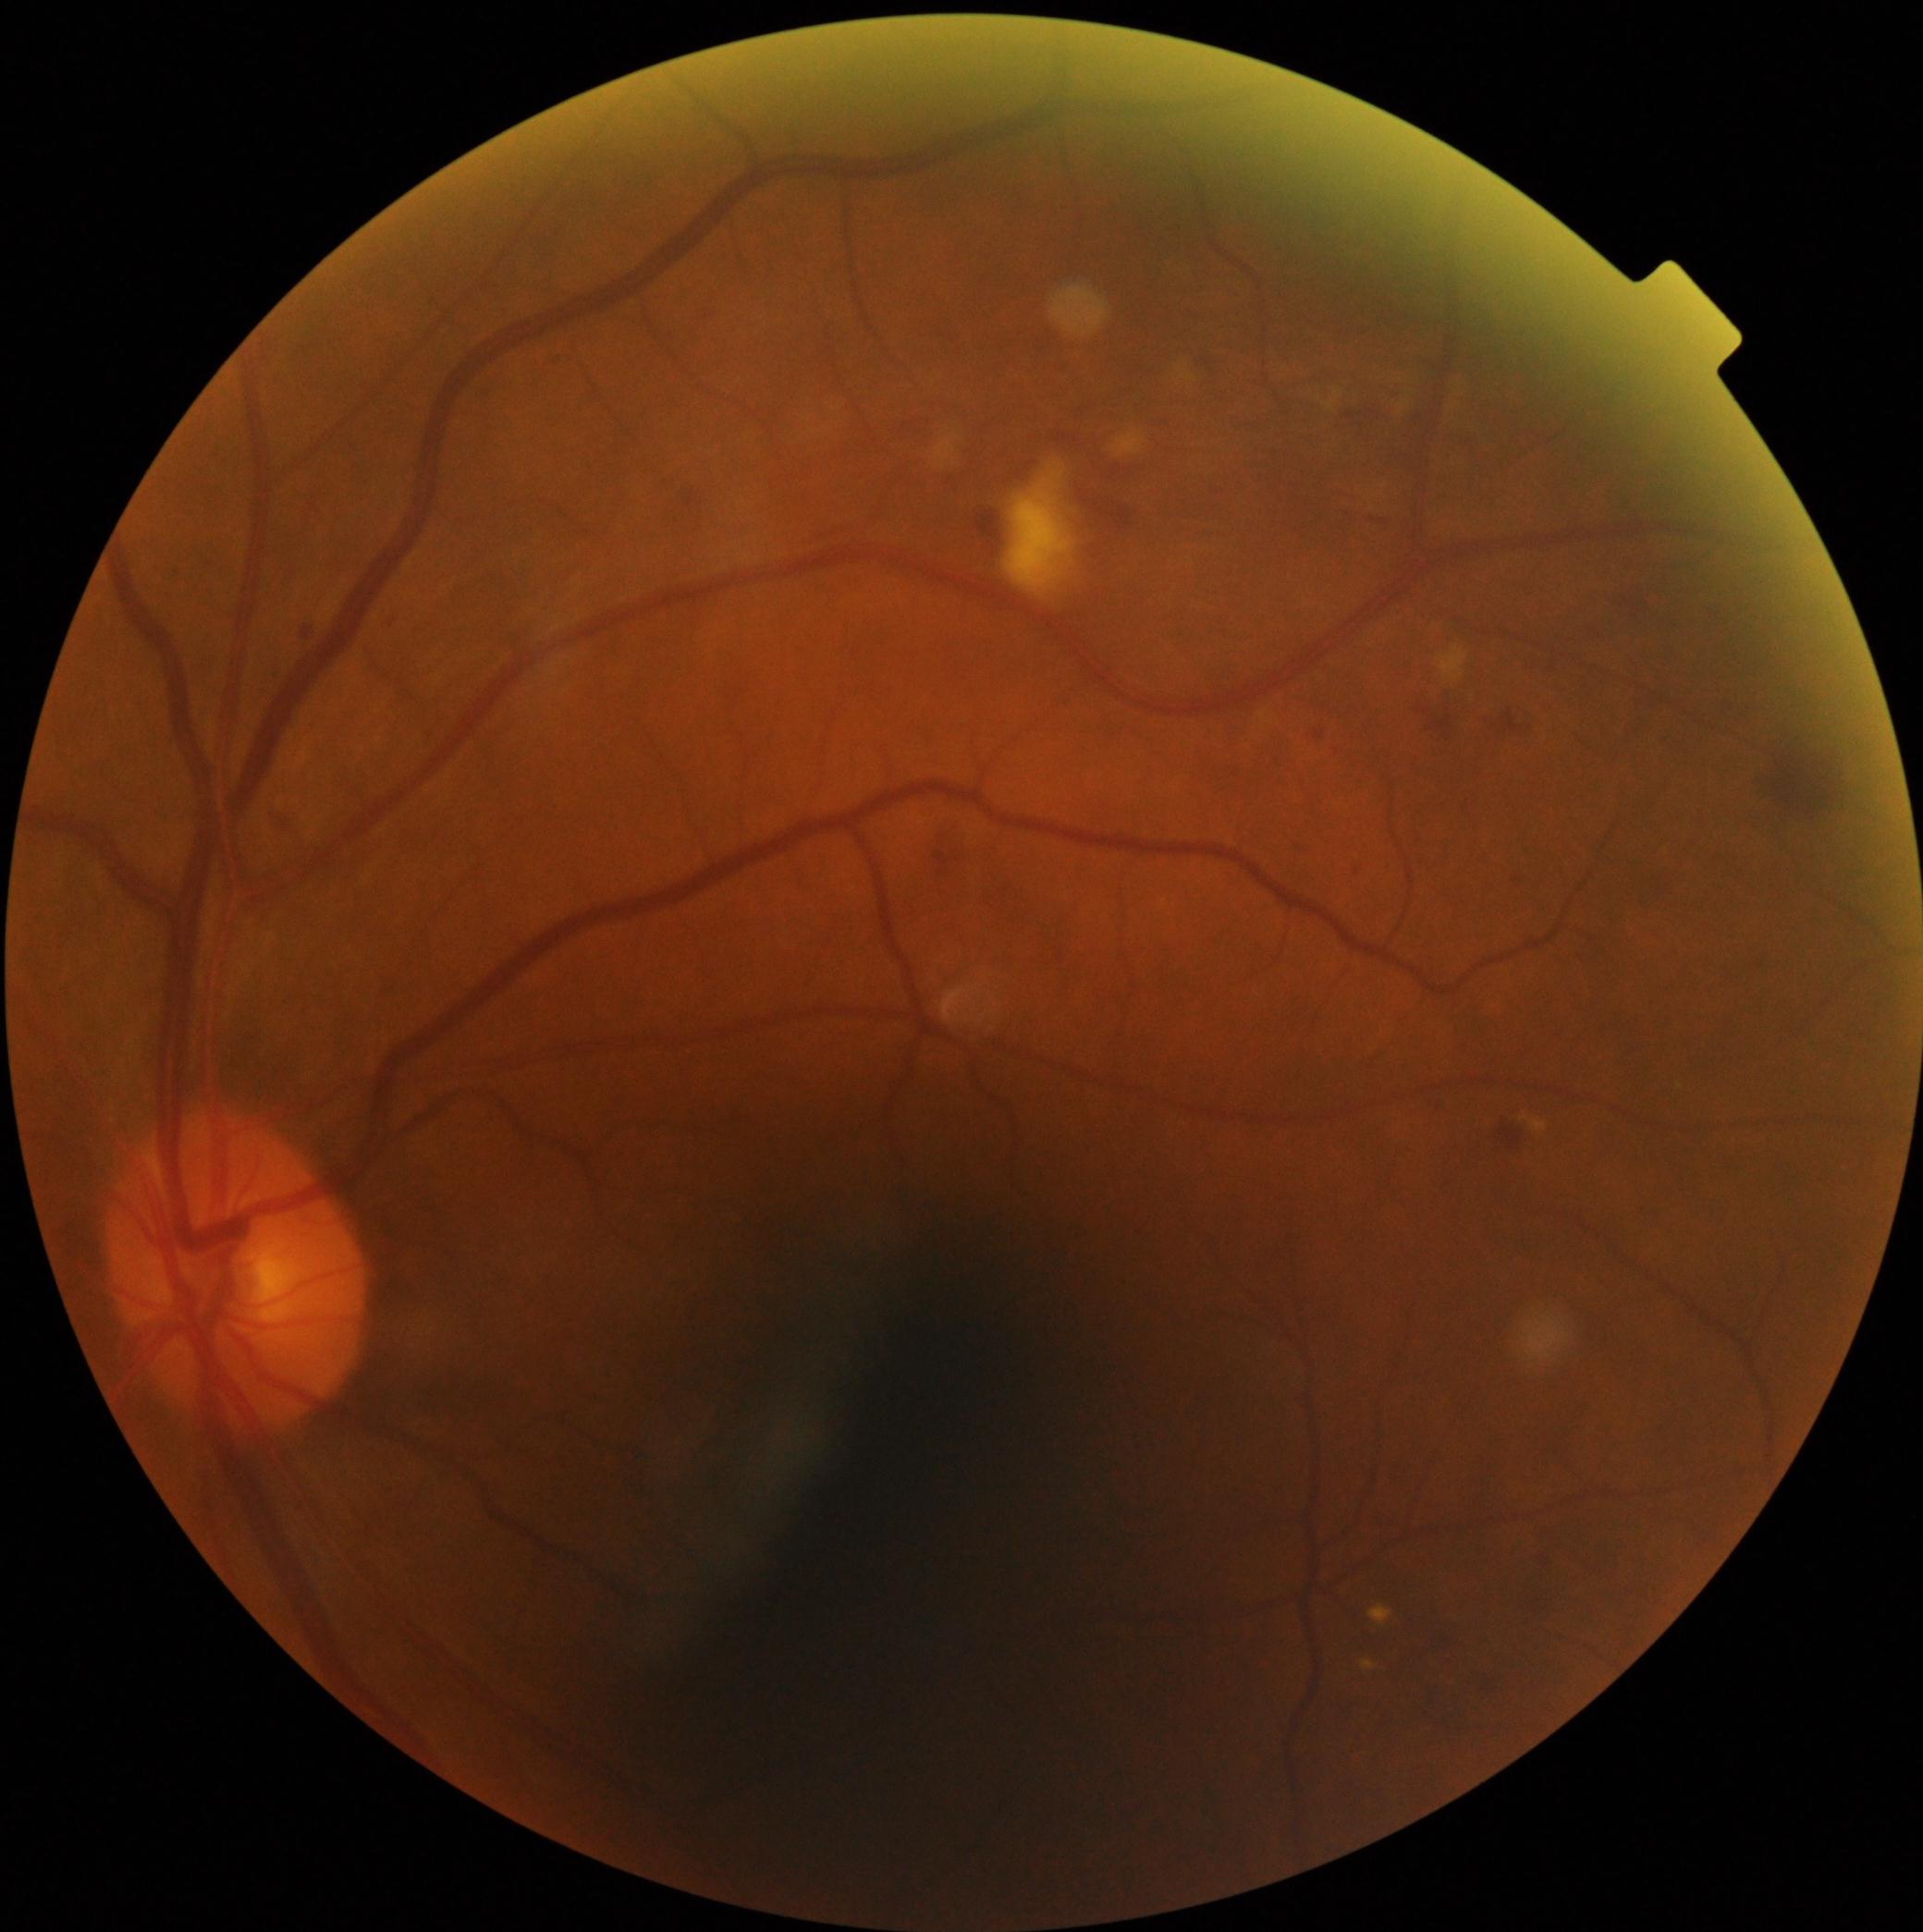

DR class: non-proliferative diabetic retinopathy. Diabetic retinopathy grade is 2.